Pediatric retinal photograph (wide-field):
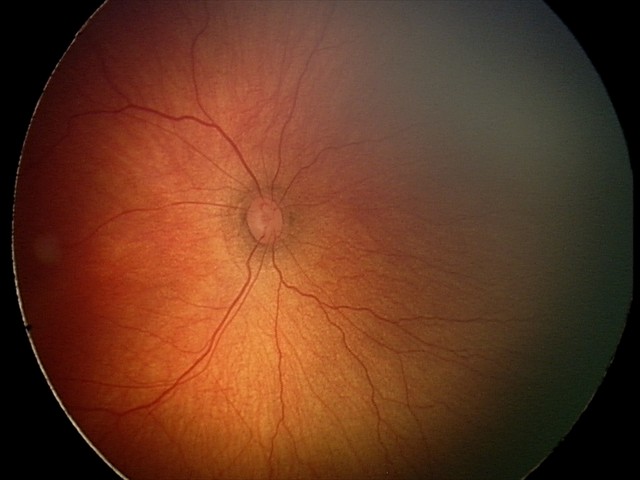

Screening: no plus disease; retinopathy of prematurity (ROP) stage 2.